Wide-field fundus photograph of an infant · captured with the Clarity RetCam 3 (130° field of view) · 640 x 480 pixels
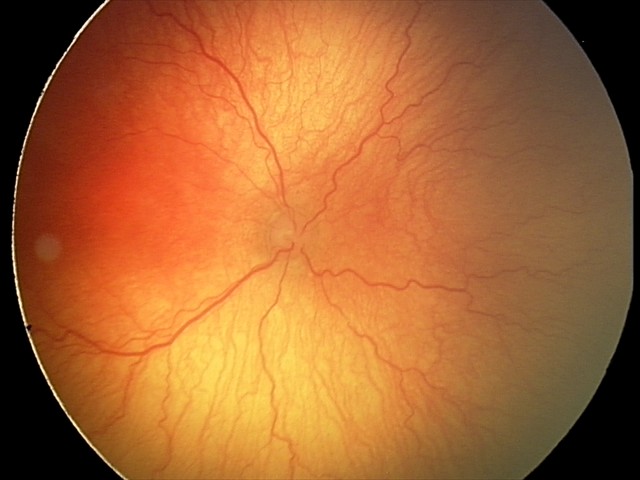 Q: What is the diagnosis from this examination?
A: aggressive retinopathy of prematurity (A-ROP)
Q: What is the plus-form classification?
A: plus disease